1440x1080px. Wide-field contact fundus photograph of an infant:
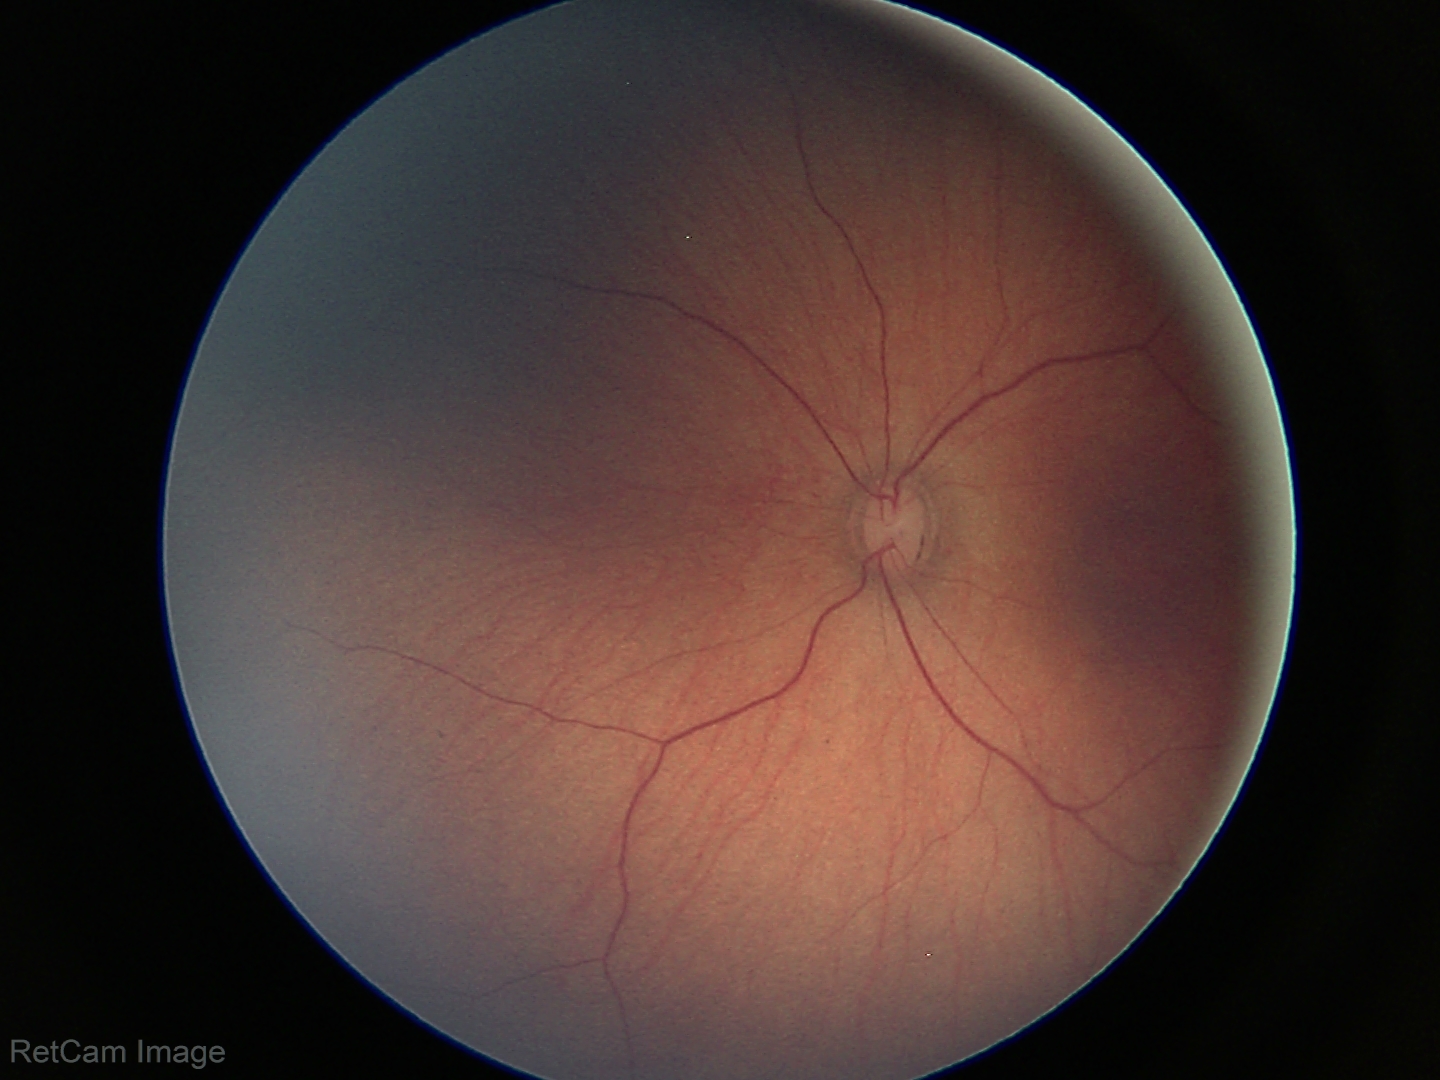 Screening examination with no abnormal retinal findings.